Acquired with a NIDEK AFC-230 — 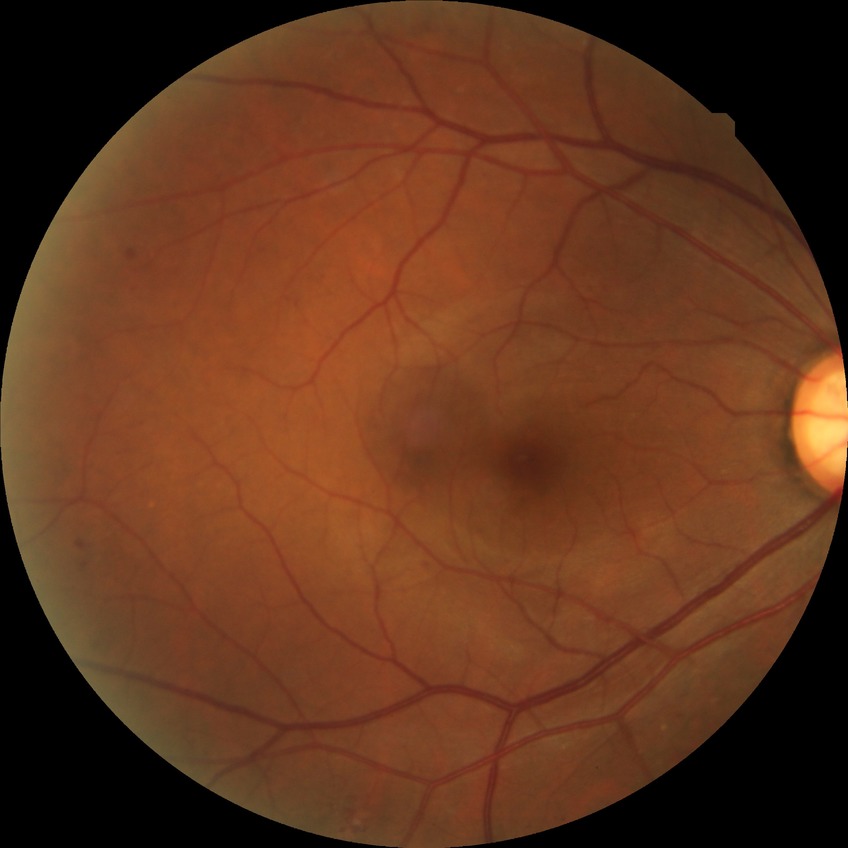
diabetic retinopathy (DR): simple diabetic retinopathy (SDR)